45° FOV: 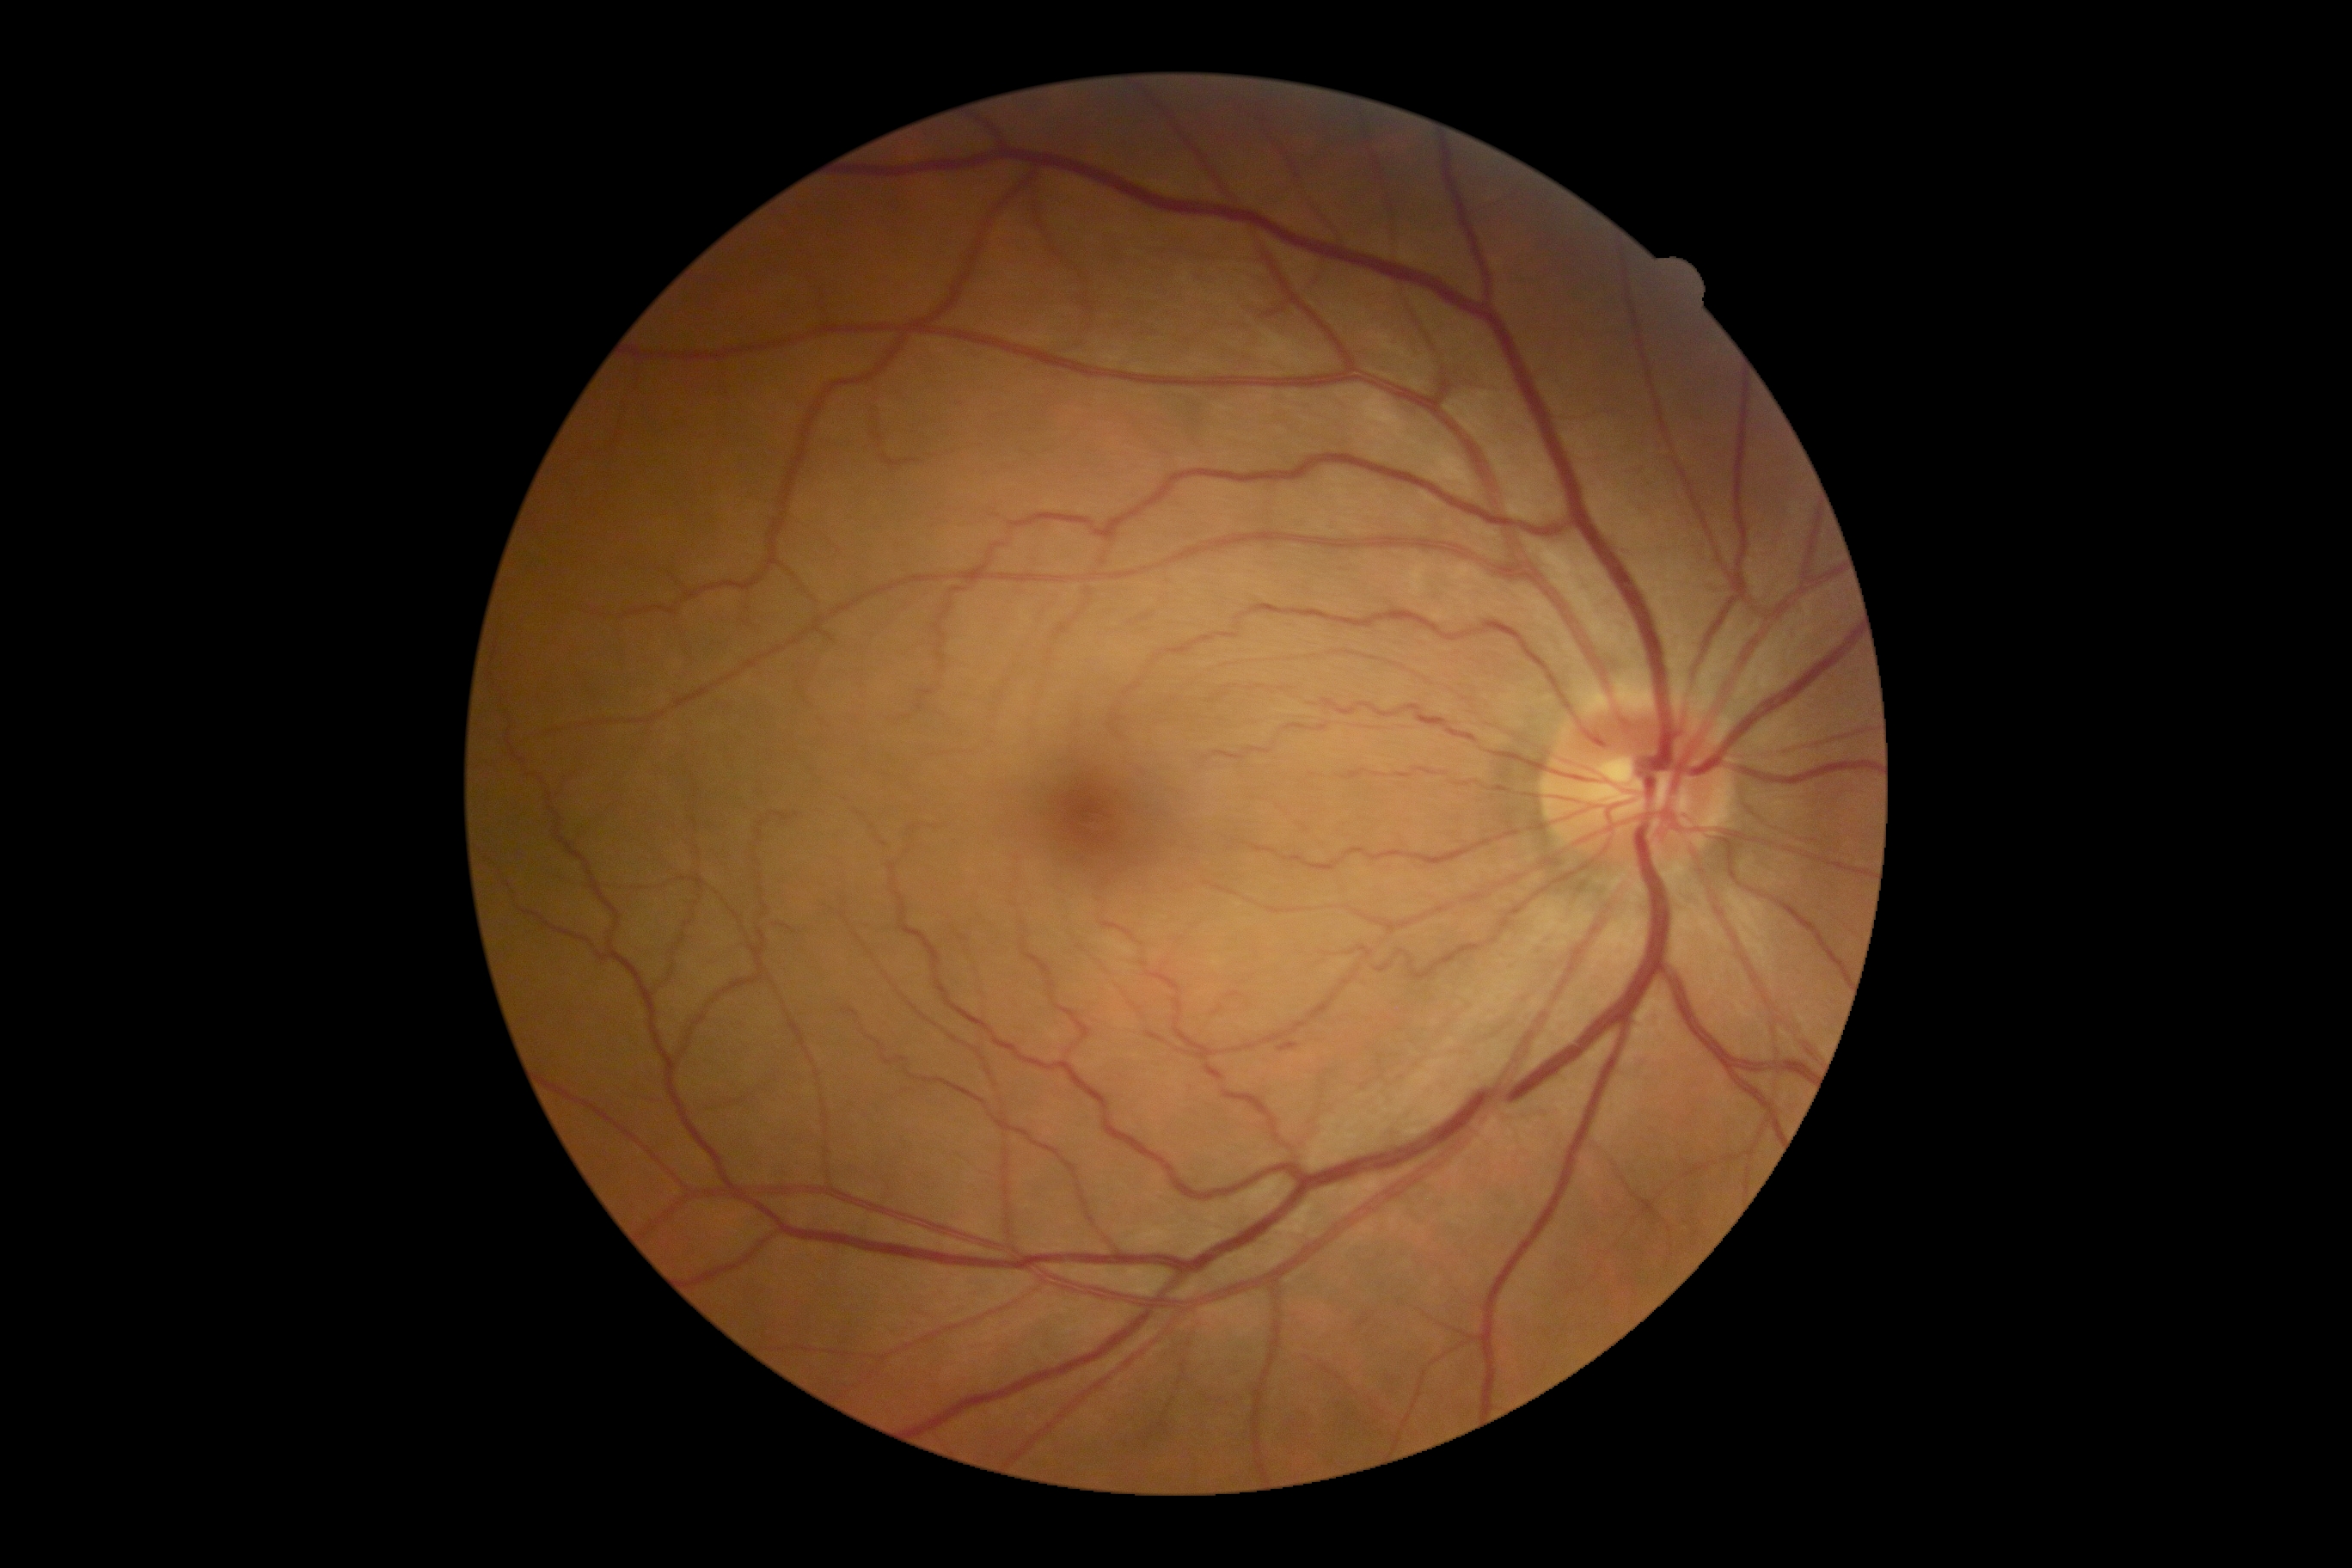
dr_grade: 2/4